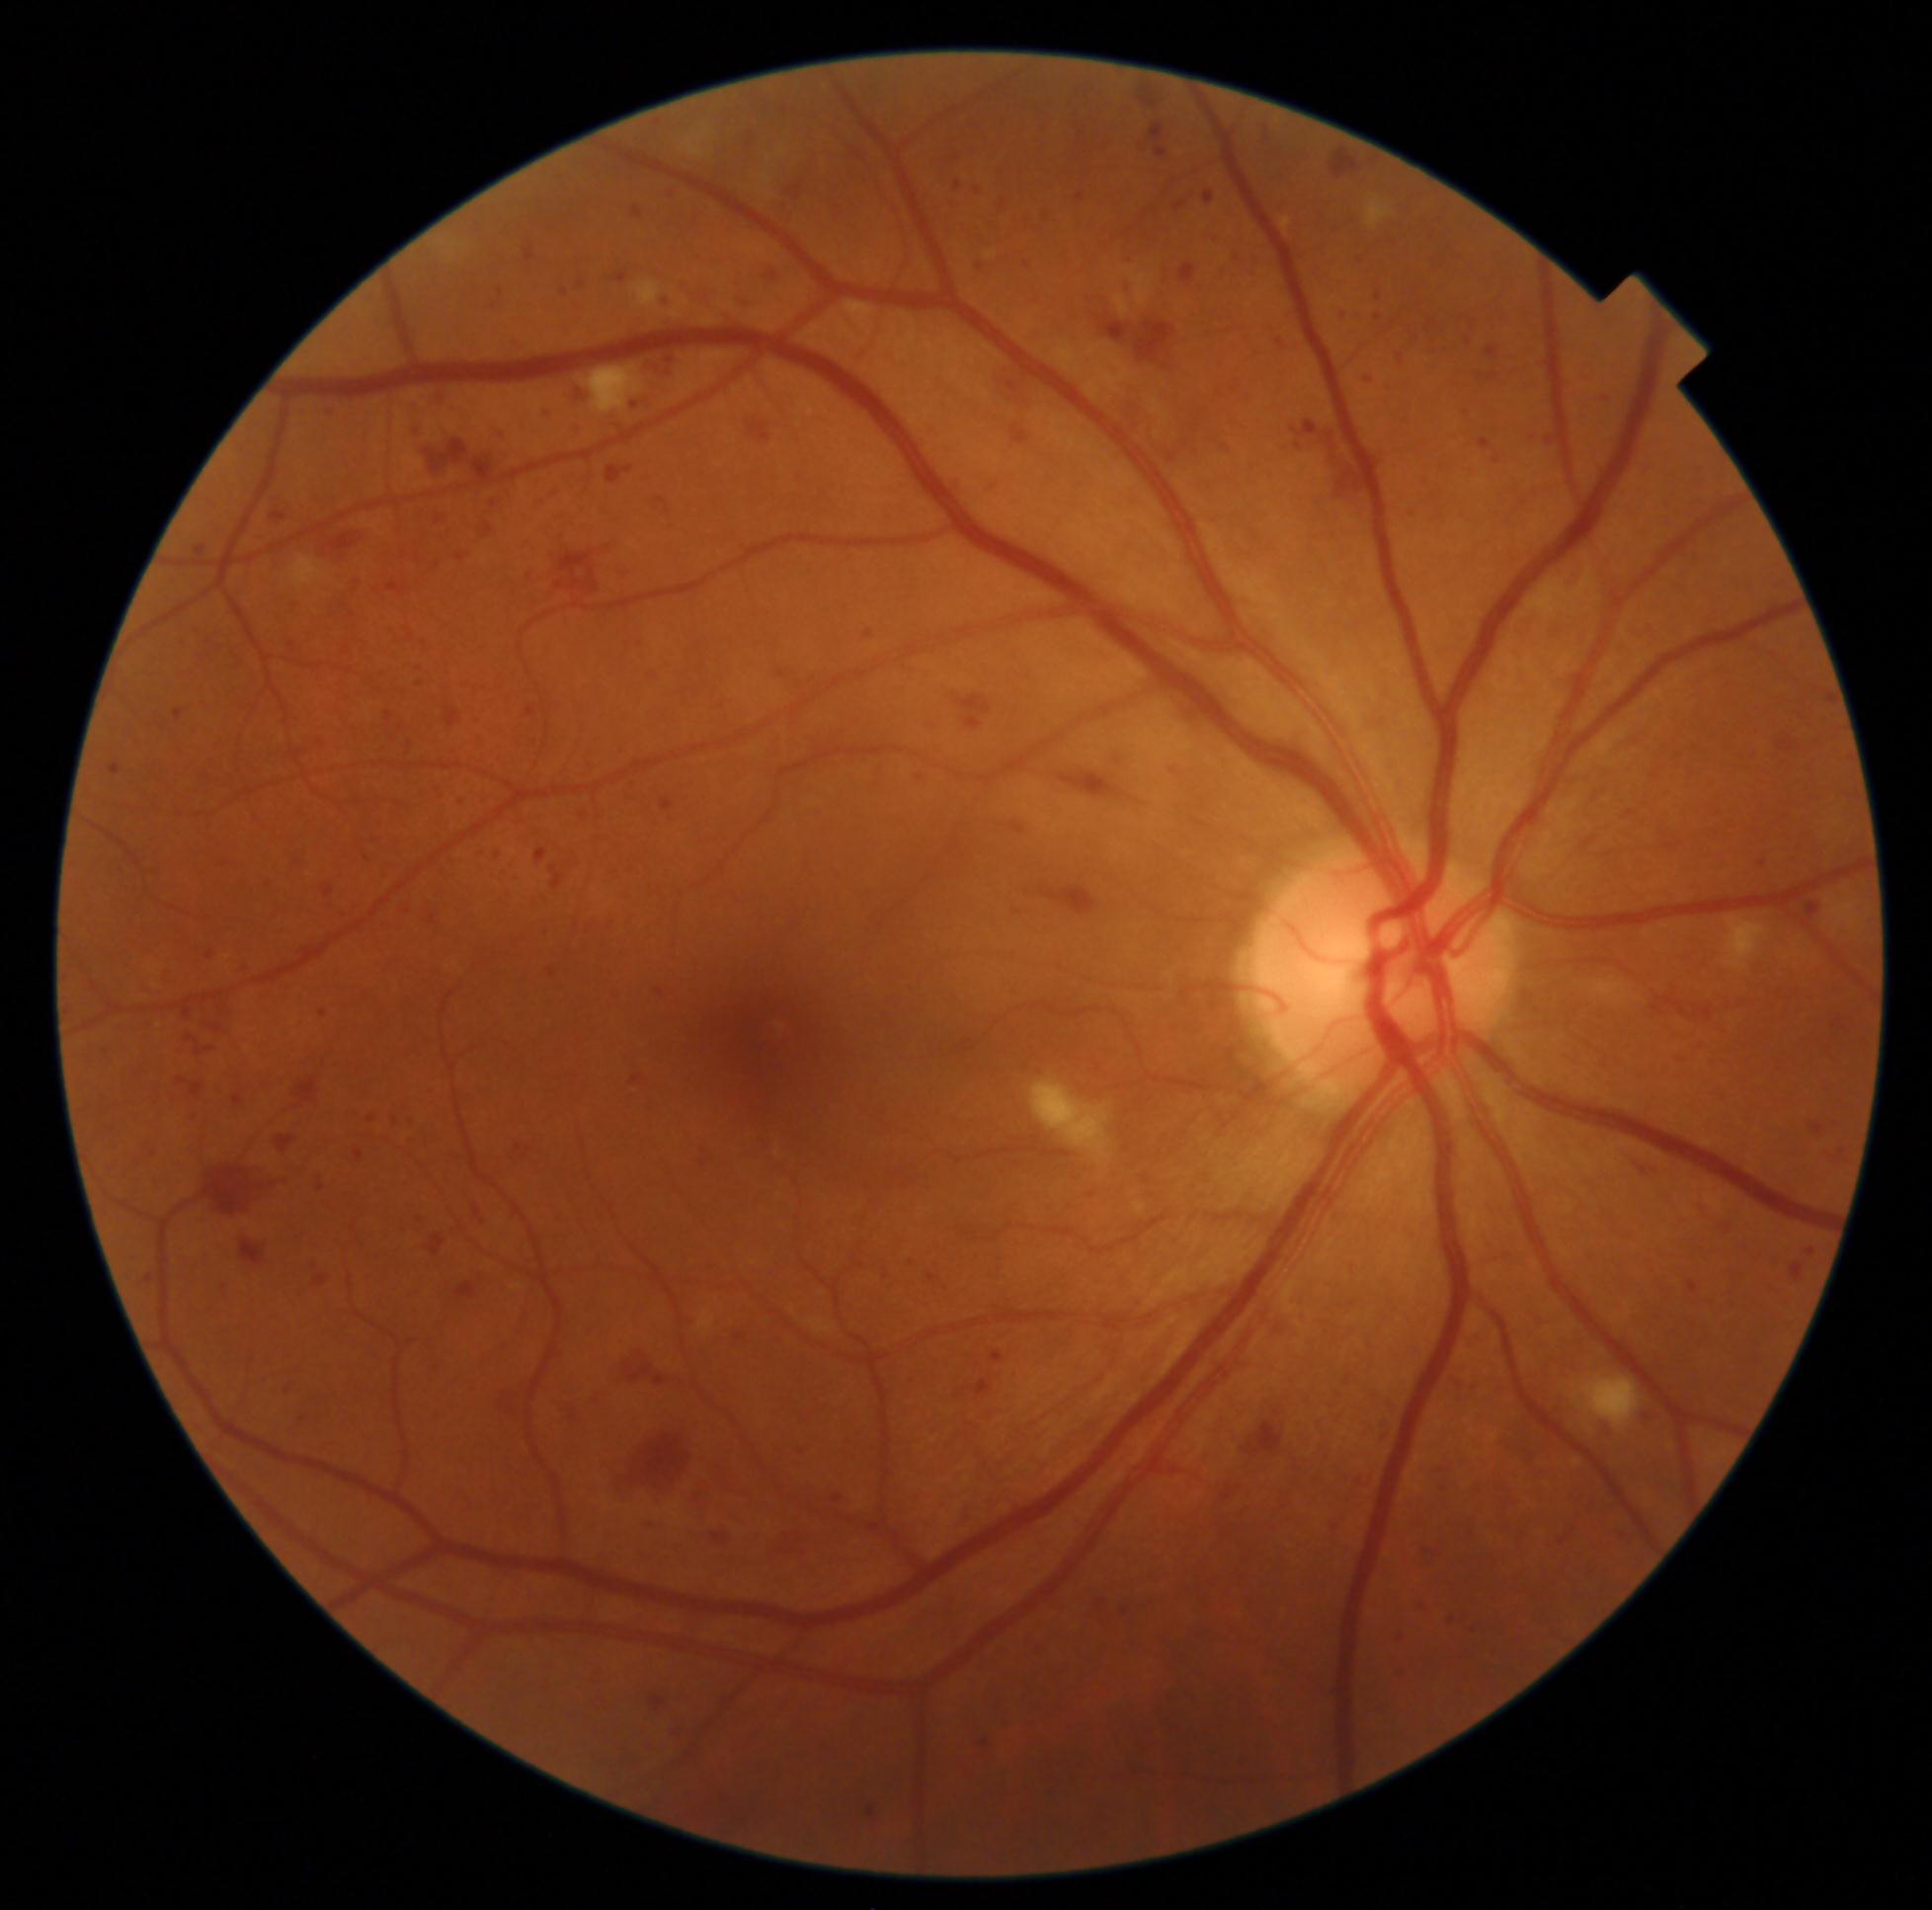 partial: true
dr_grade: 3
dr_grade_name: severe NPDR
lesions:
  he:
    - box(386, 585, 407, 596)
    - box(634, 208, 643, 219)
    - box(281, 1381, 296, 1398)
    - box(1686, 1279, 1702, 1295)
    - box(1673, 1040, 1713, 1065)
    - box(727, 255, 759, 310)
    - box(1180, 264, 1196, 283)
    - box(1807, 1118, 1830, 1140)
    - box(1419, 1545, 1441, 1564)
    - box(312, 1170, 327, 1193)
    - box(928, 1274, 935, 1283)
    - box(405, 1117, 420, 1129)
    - box(1479, 438, 1492, 449)
    - box(1488, 348, 1500, 358)
    - box(199, 1162, 293, 1220)
    - box(415, 677, 433, 688)
    - box(532, 845, 550, 867)
    - box(1591, 1420, 1616, 1445)
  he_small_centers:
    - <pt>439,521</pt>
    - <pt>979,193</pt>